Wide-field fundus photograph from neonatal ROP screening · Clarity RetCam 3, 130° FOV — 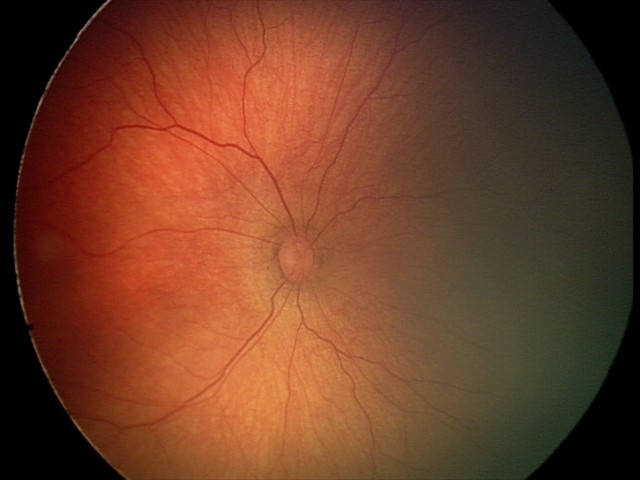
Assessment: ROP stage 2; plus disease: absent — posterior pole vessels without abnormal dilation or tortuosity.